Phoenix ICON wide-field infant fundus image; 1240x1240px — 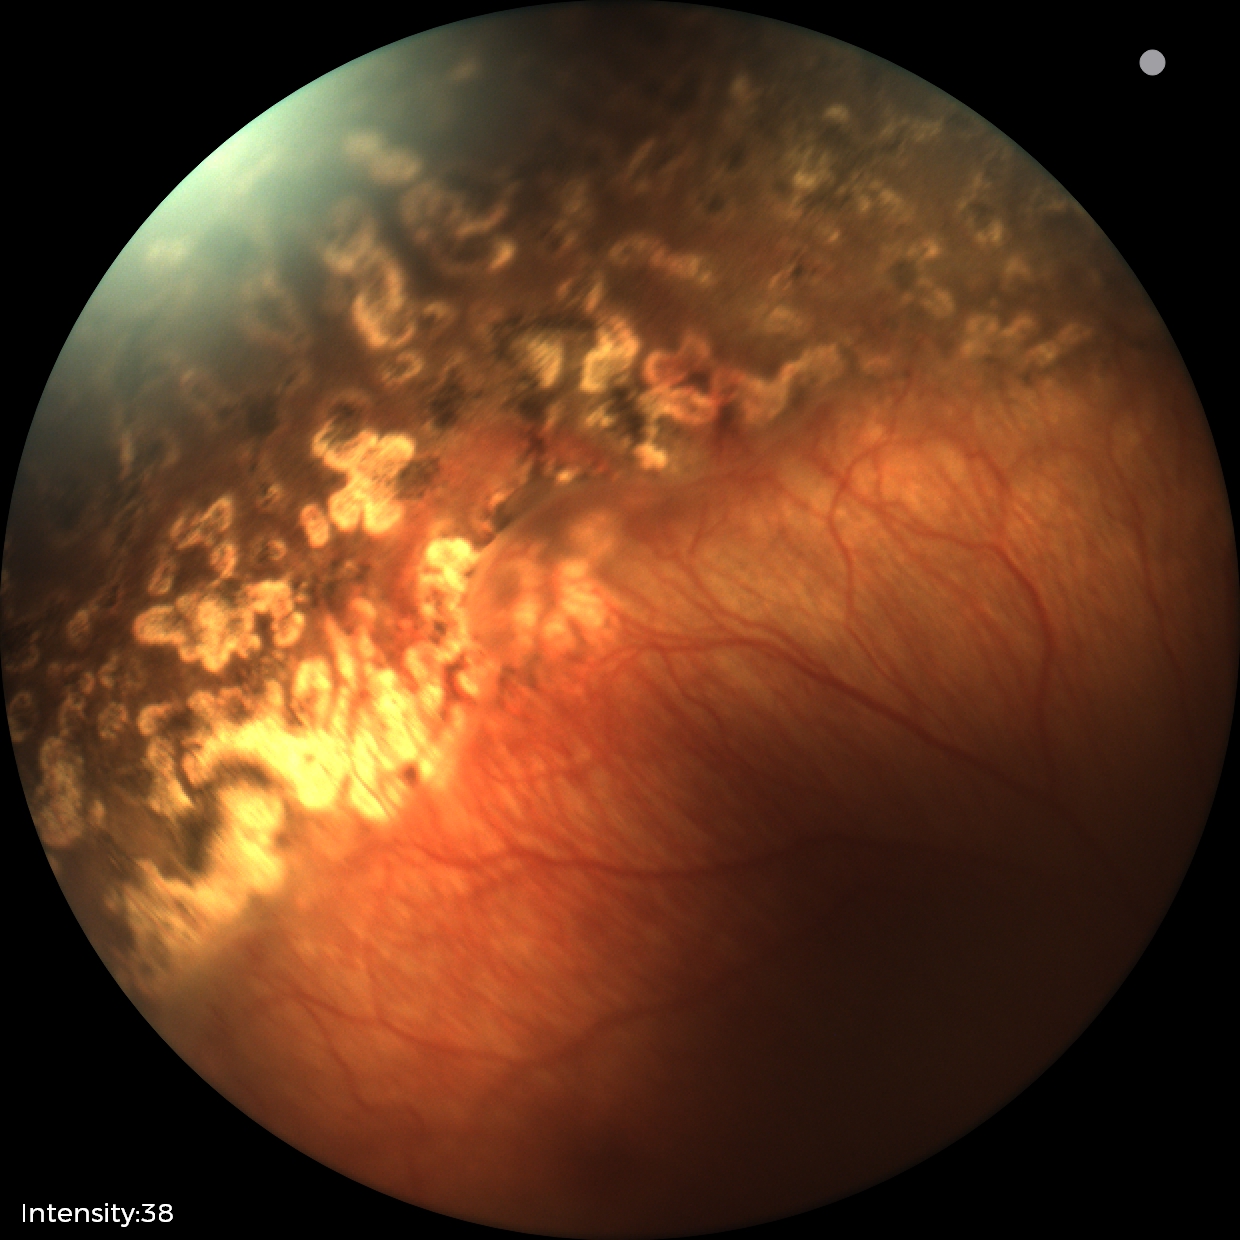

Screening series with status post ROP.